2048x1536px — 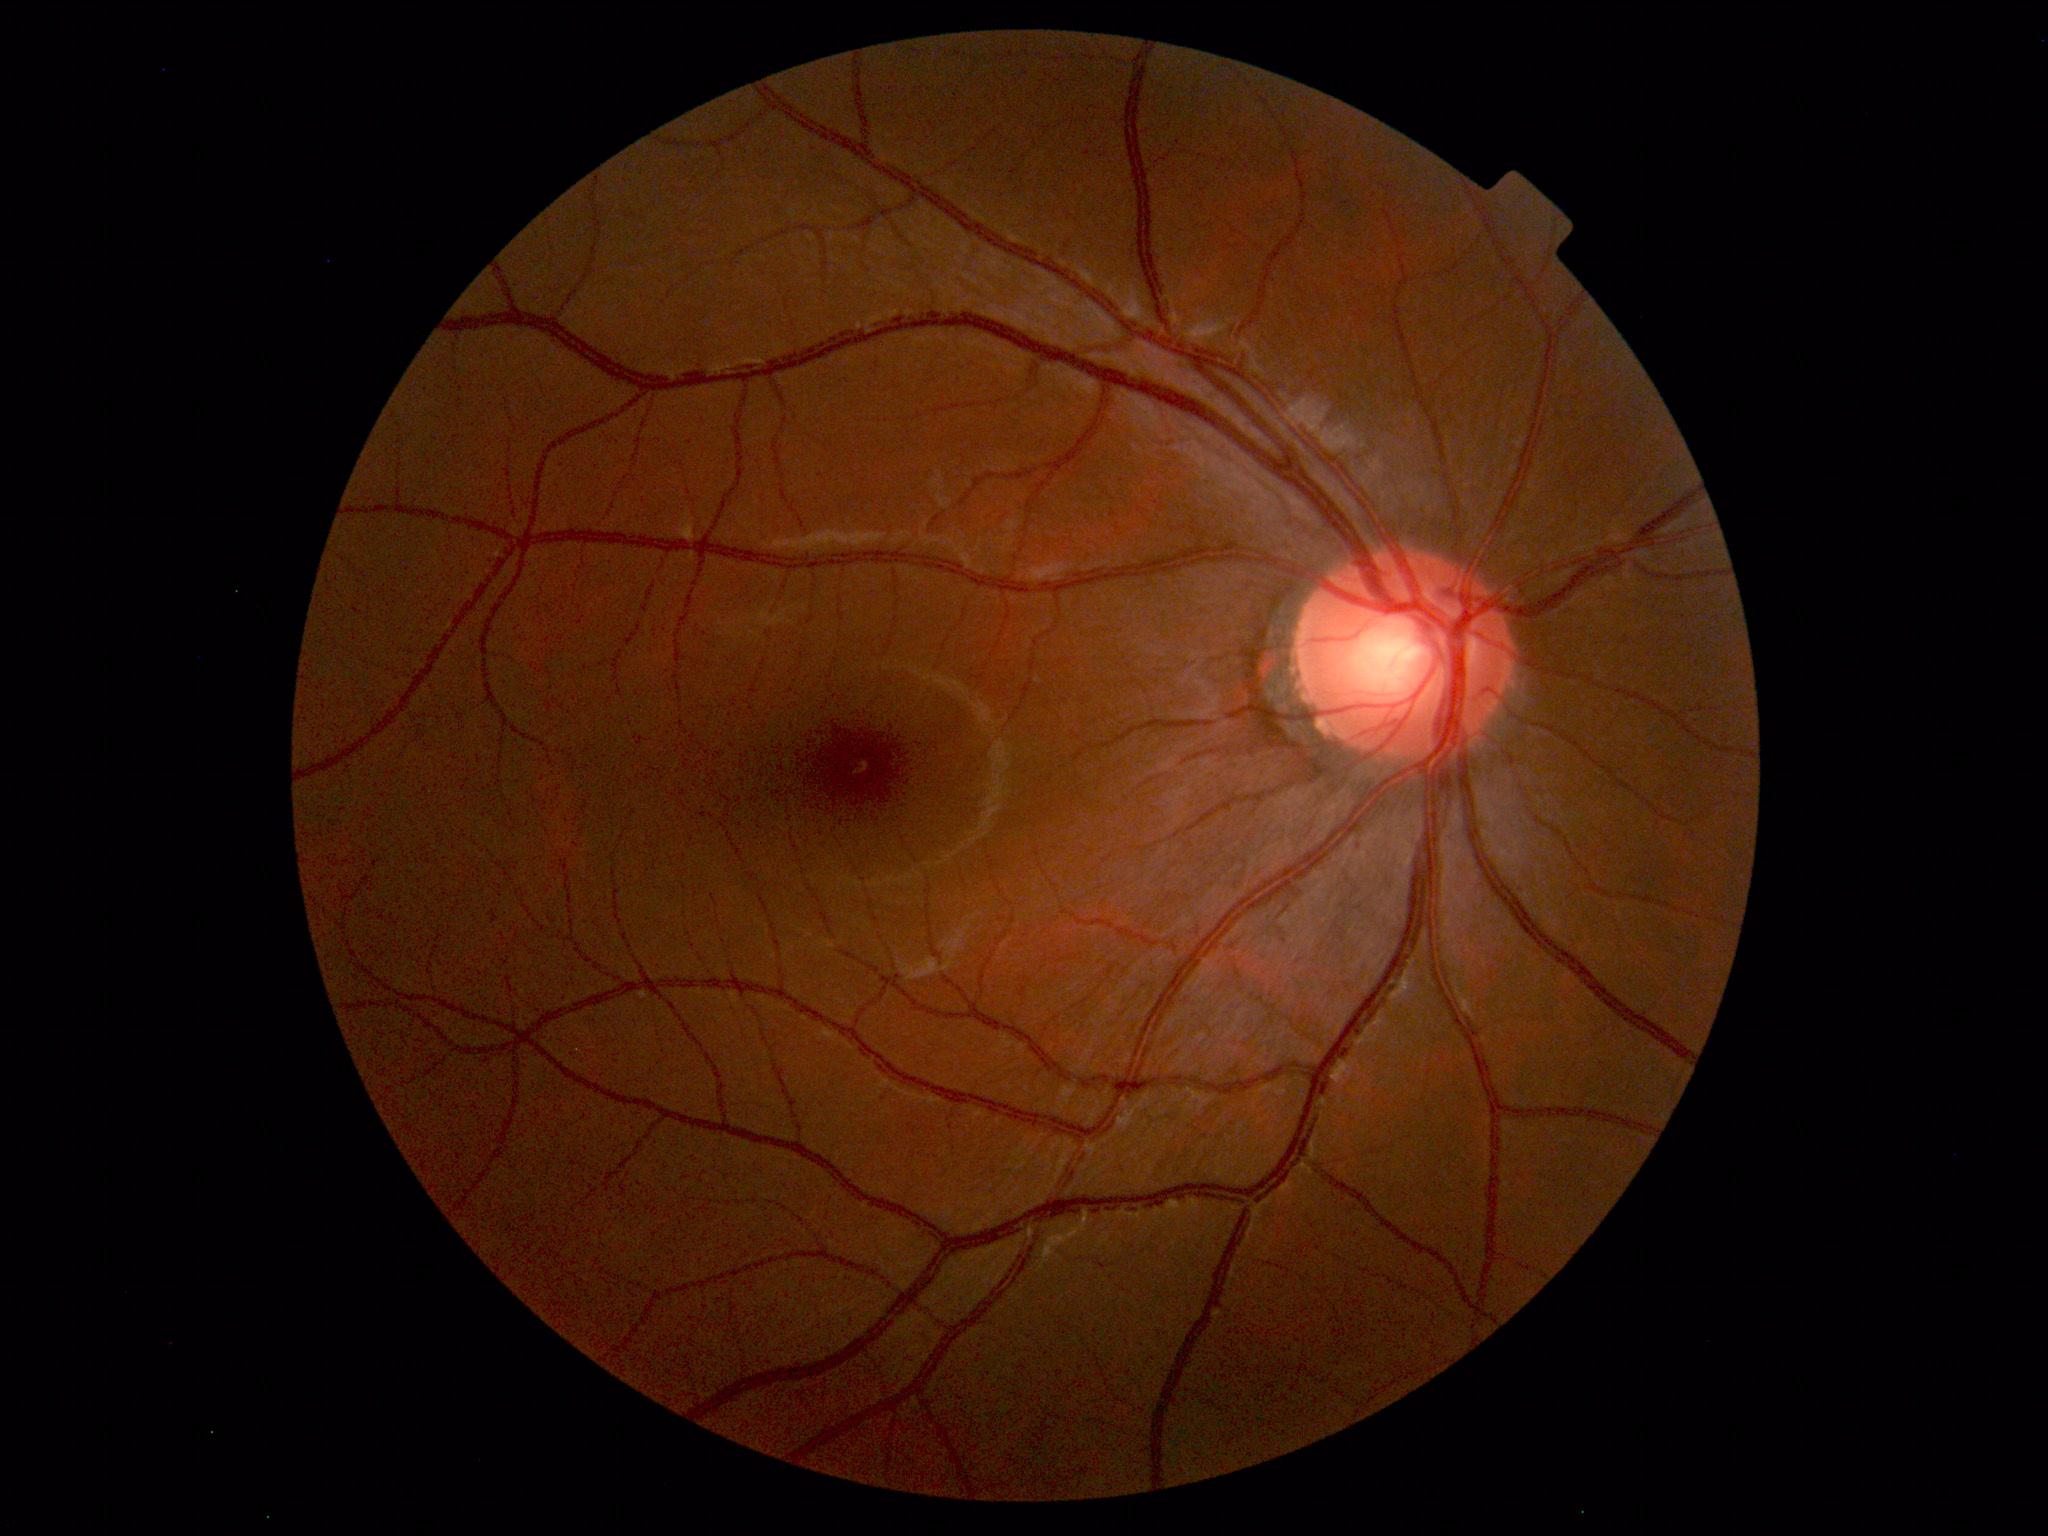 Impression: normal fundus.